No pharmacologic dilation, 45 degree fundus photograph, acquired with a NIDEK AFC-230, CFP: 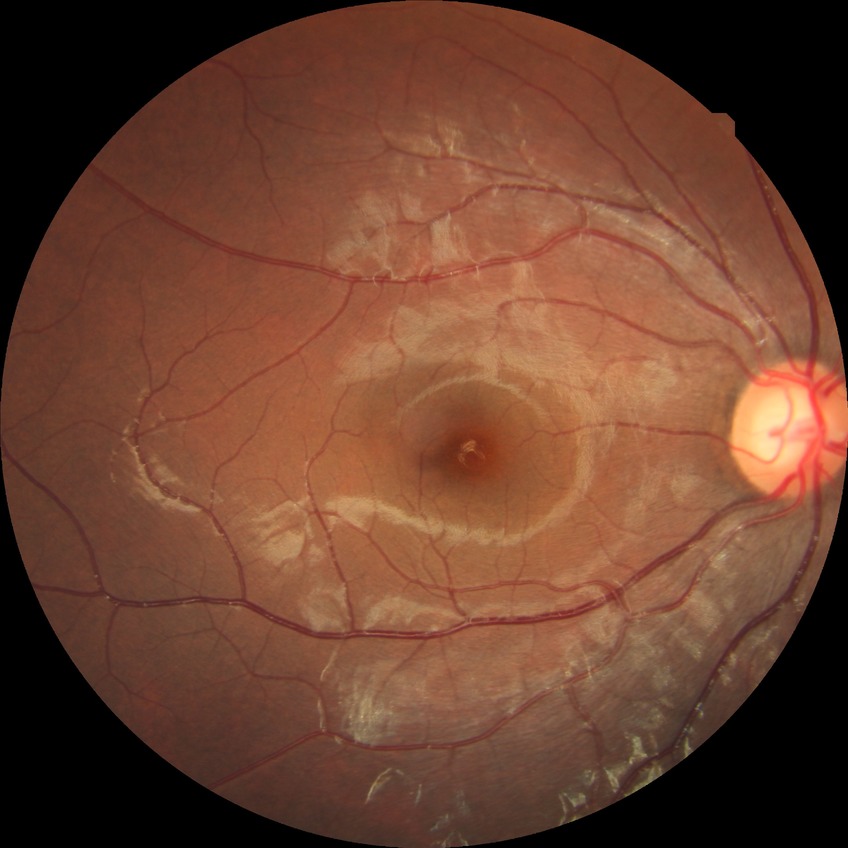
Retinopathy grade: no diabetic retinopathy.